640x480px; wide-field fundus image from infant ROP screening — 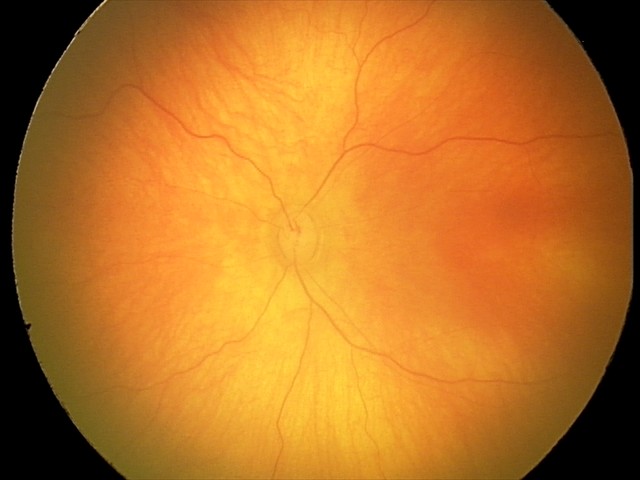
Physiological retinal appearance for postconceptual age.